1240 x 1240 pixels. Infant wide-field retinal image
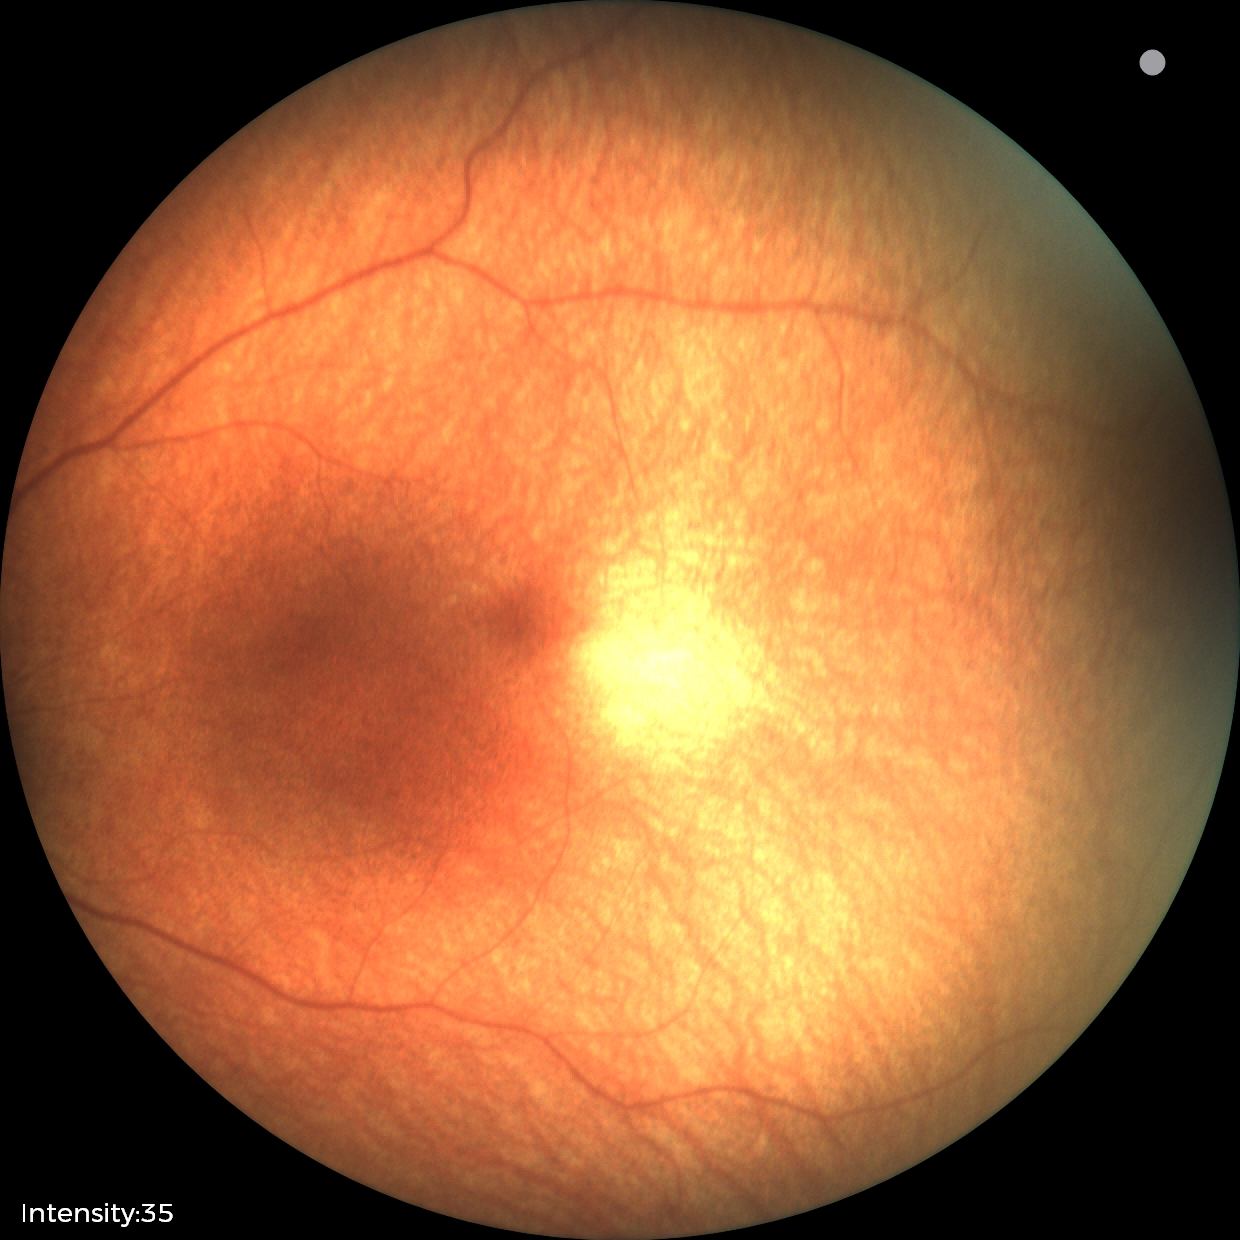 Screening examination diagnosed as physiological.